848x848px: 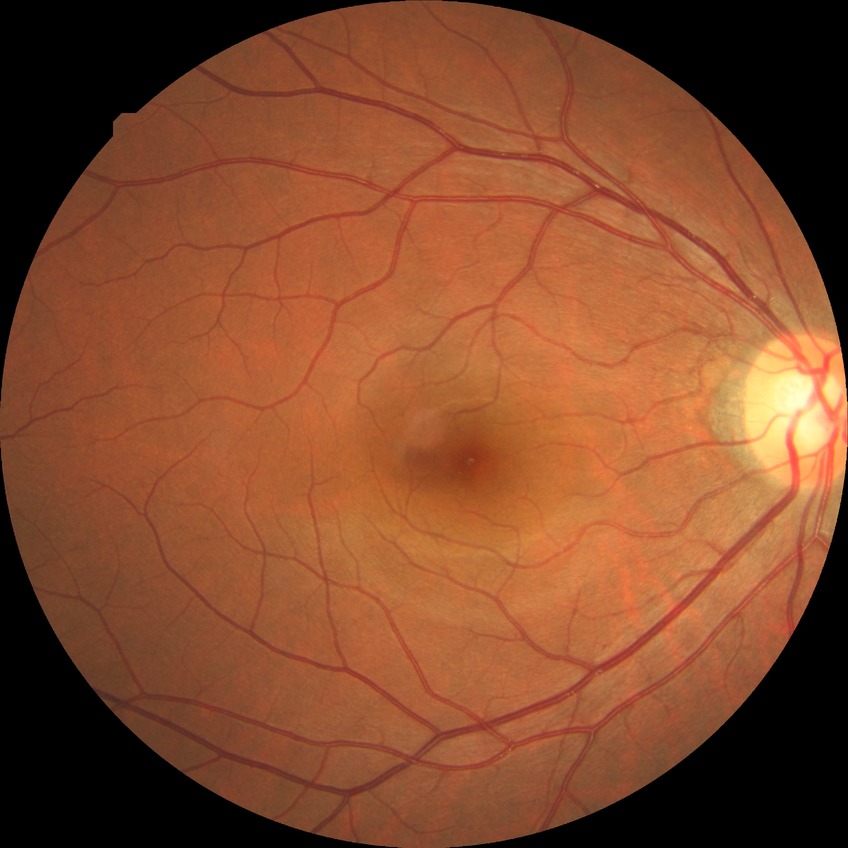
  davis_grade: no diabetic retinopathy (NDR)